Wide-field fundus photograph of an infant. 130° field of view (Natus RetCam Envision)
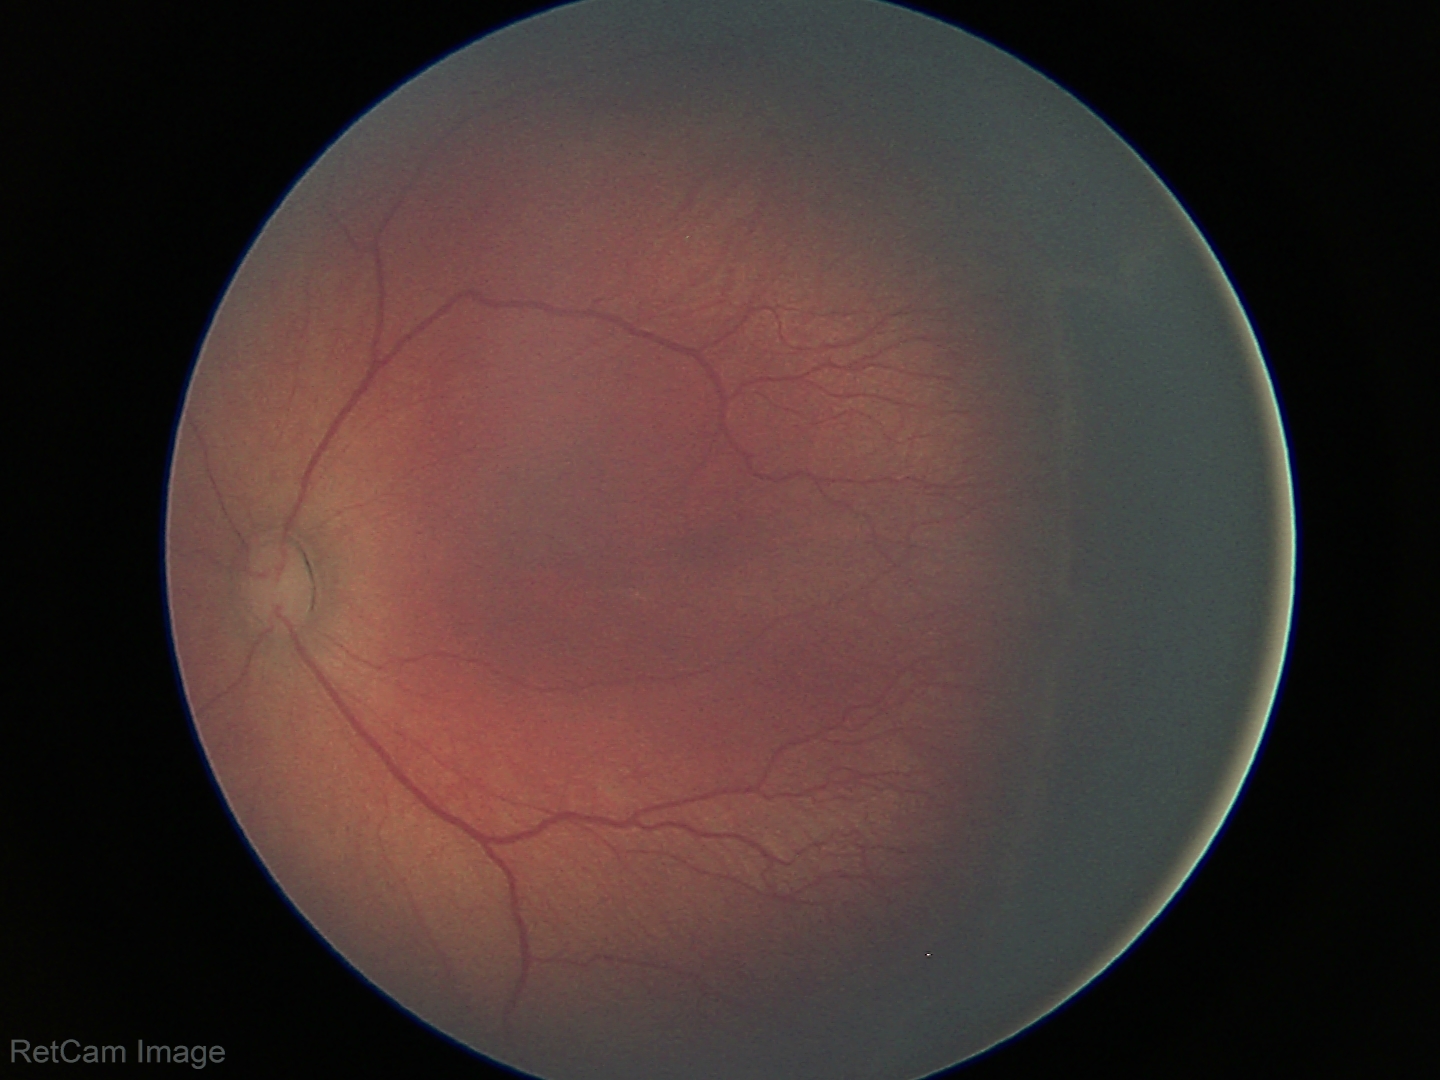
Examination diagnosed as retinopathy of prematurity stage 2.